Nidek AFC-330: 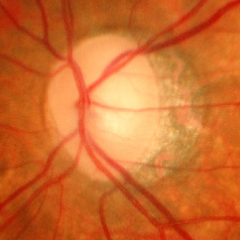
Early-stage glaucoma.